Fundus photo, 2048x1536 — 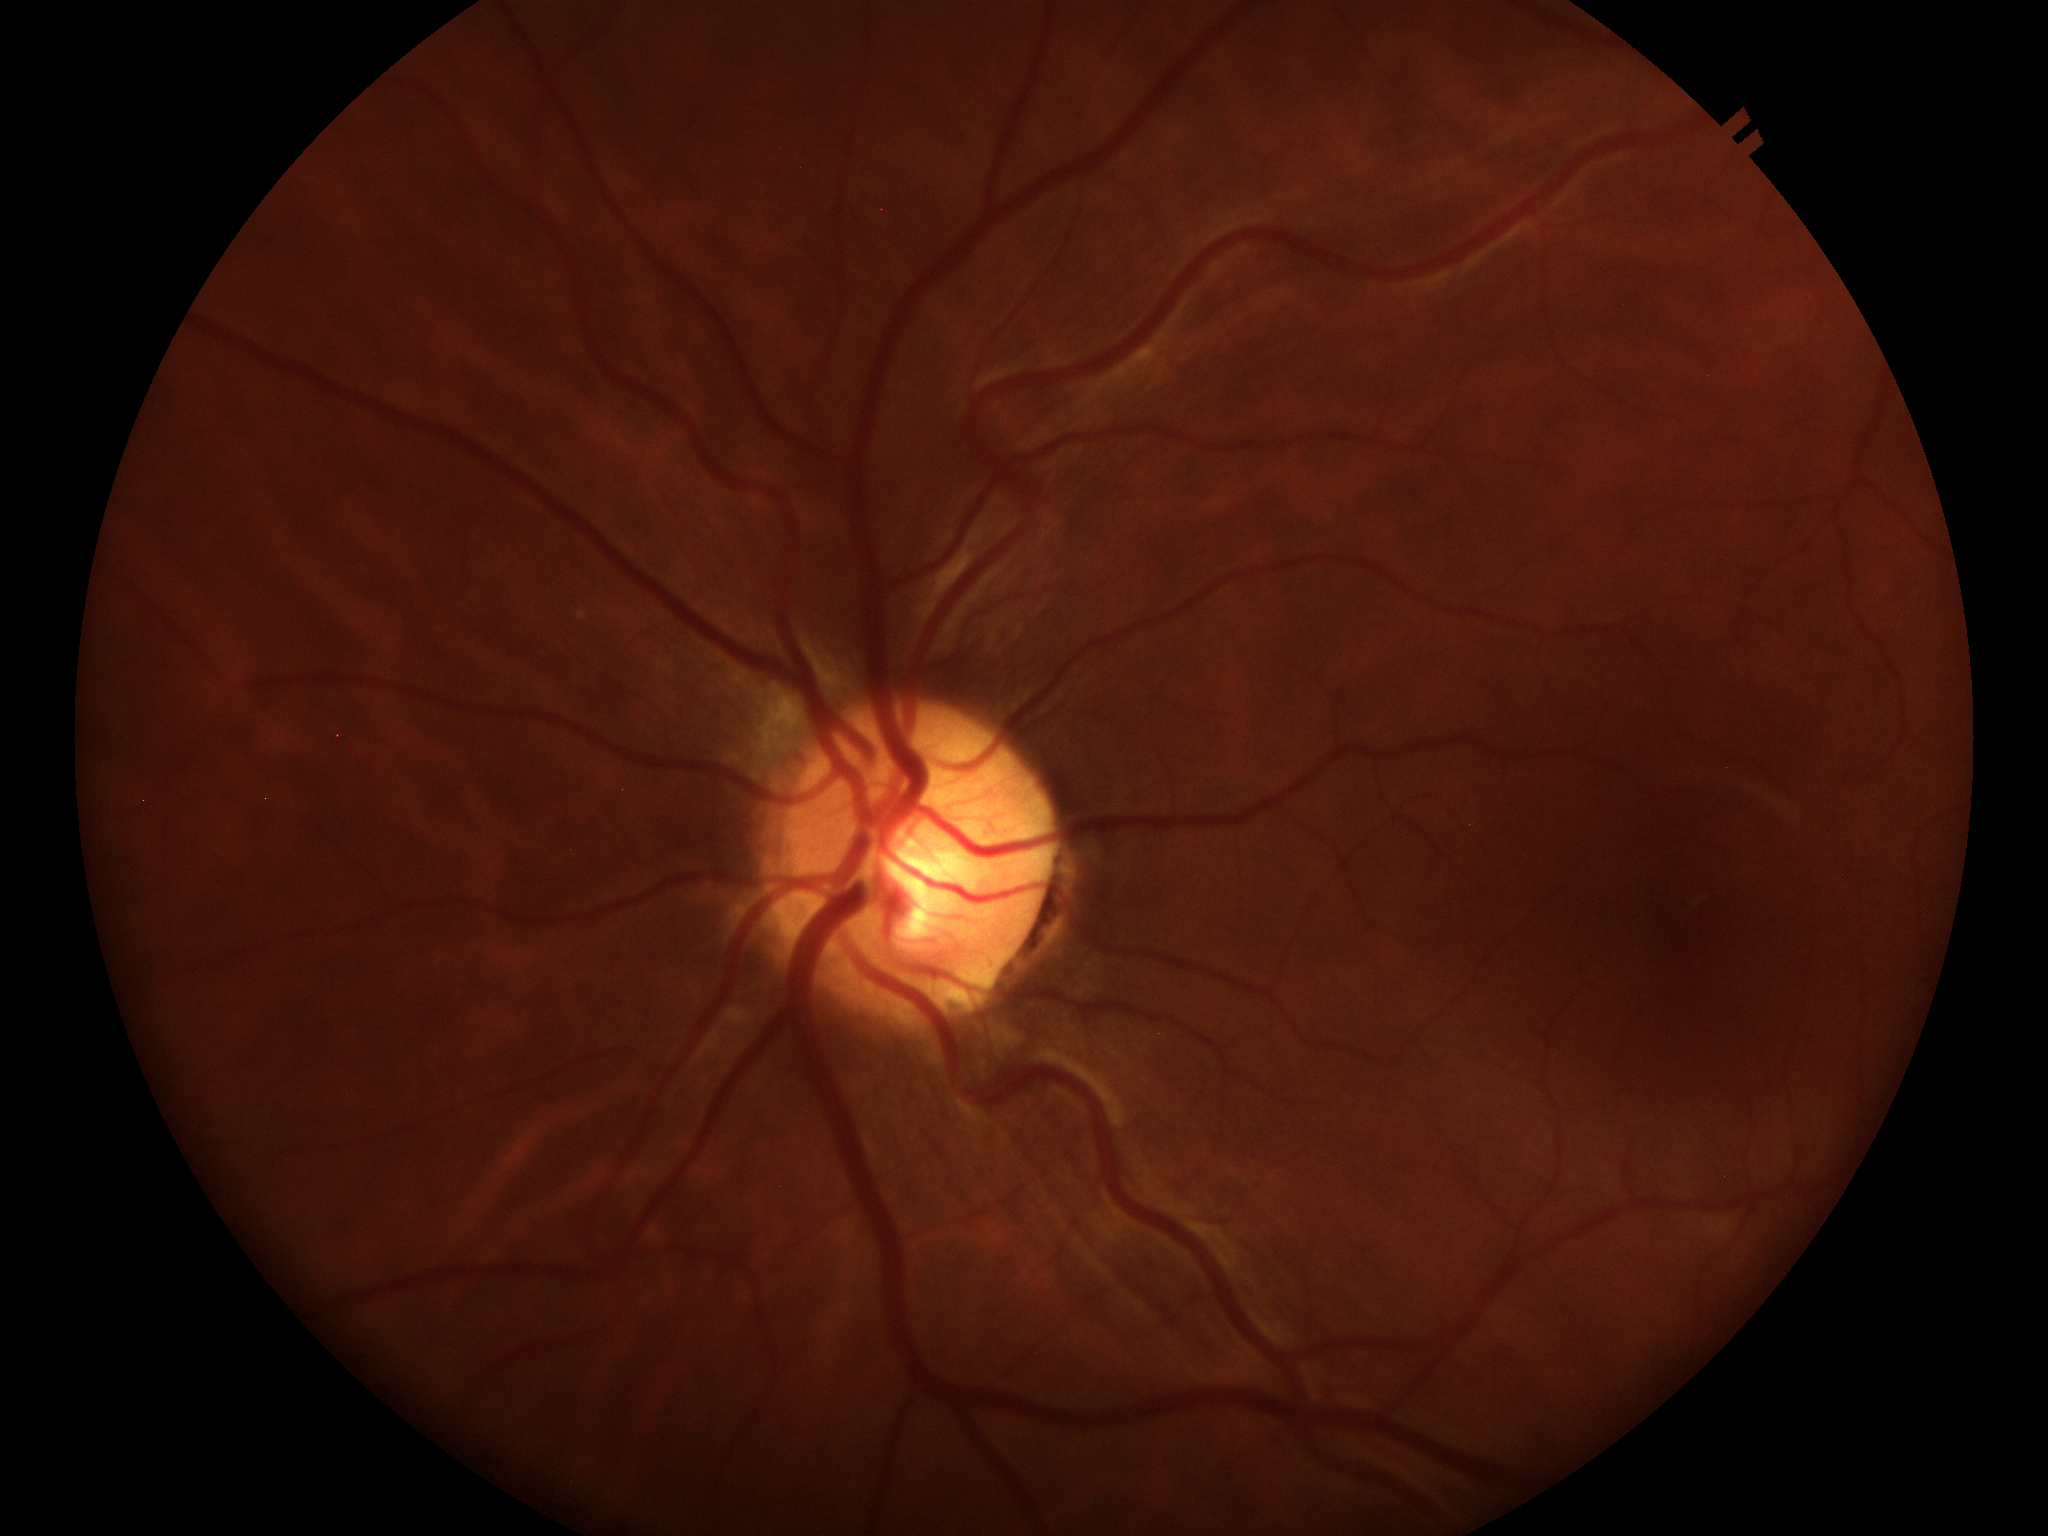

No glaucomatous optic neuropathy.
Vertical CDR: 0.54.
Horizontal C/D ratio: 0.43.